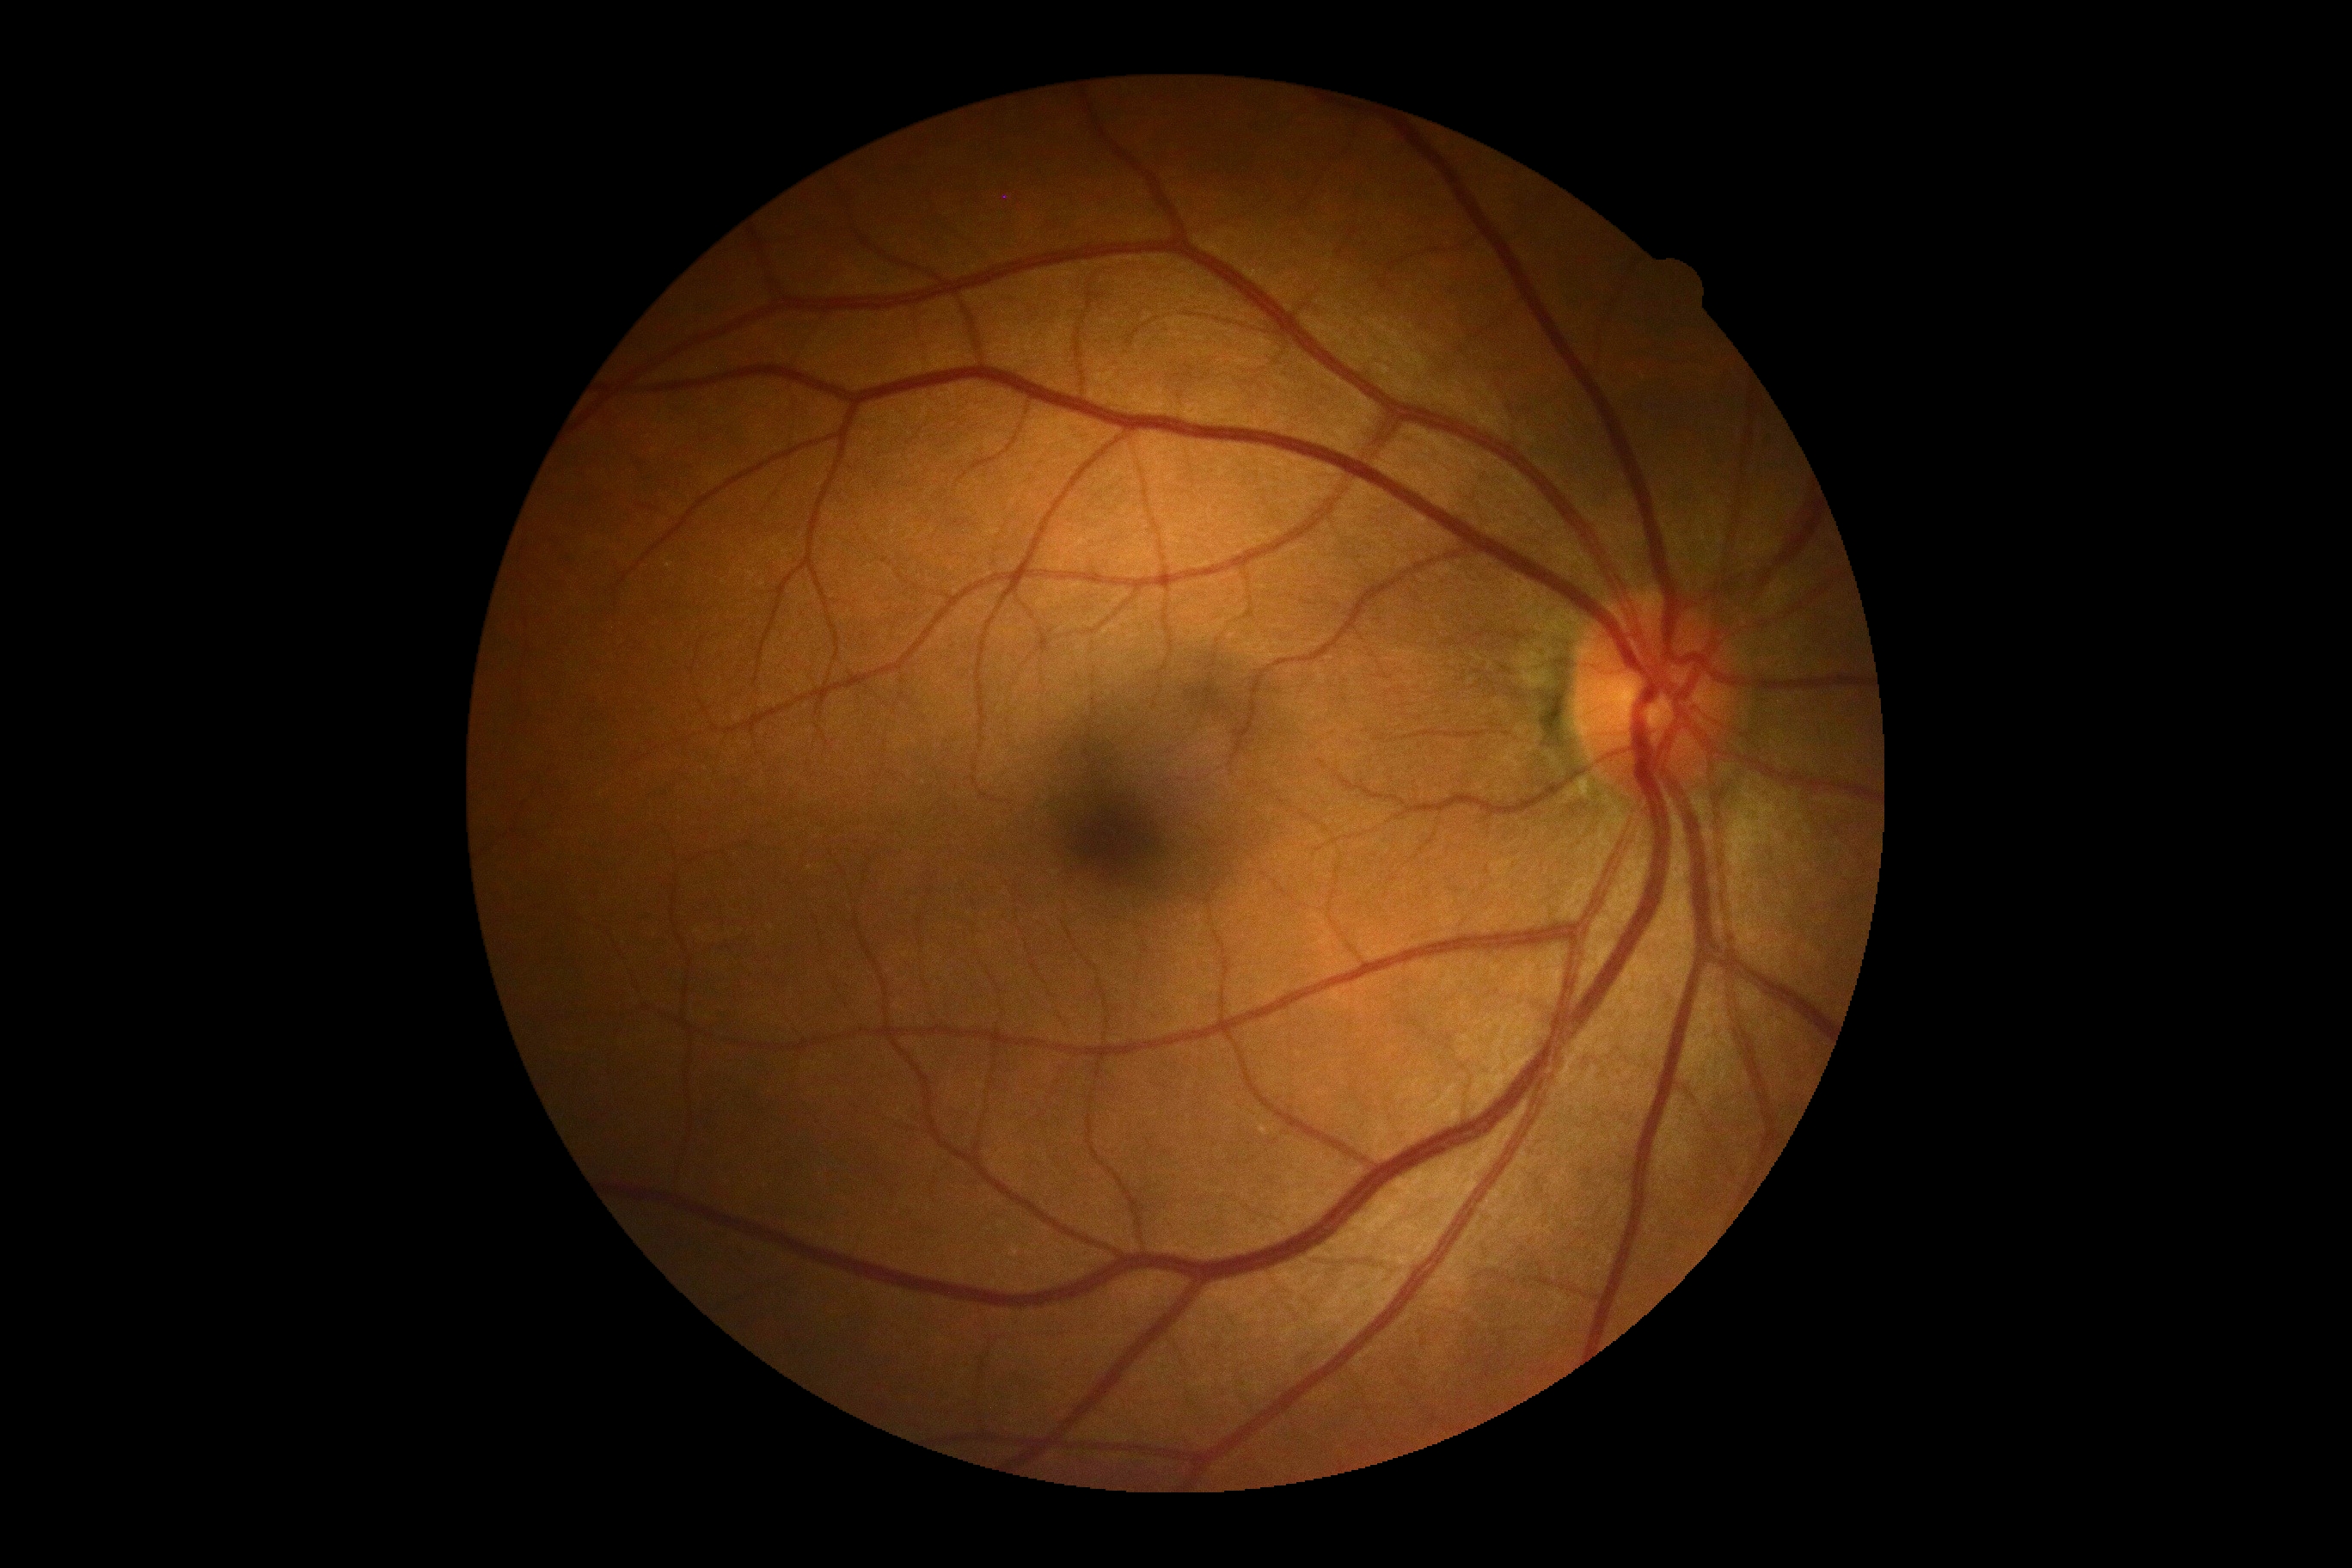   dr_impression: negative for DR
  dr_grade: grade 0 (no apparent retinopathy)